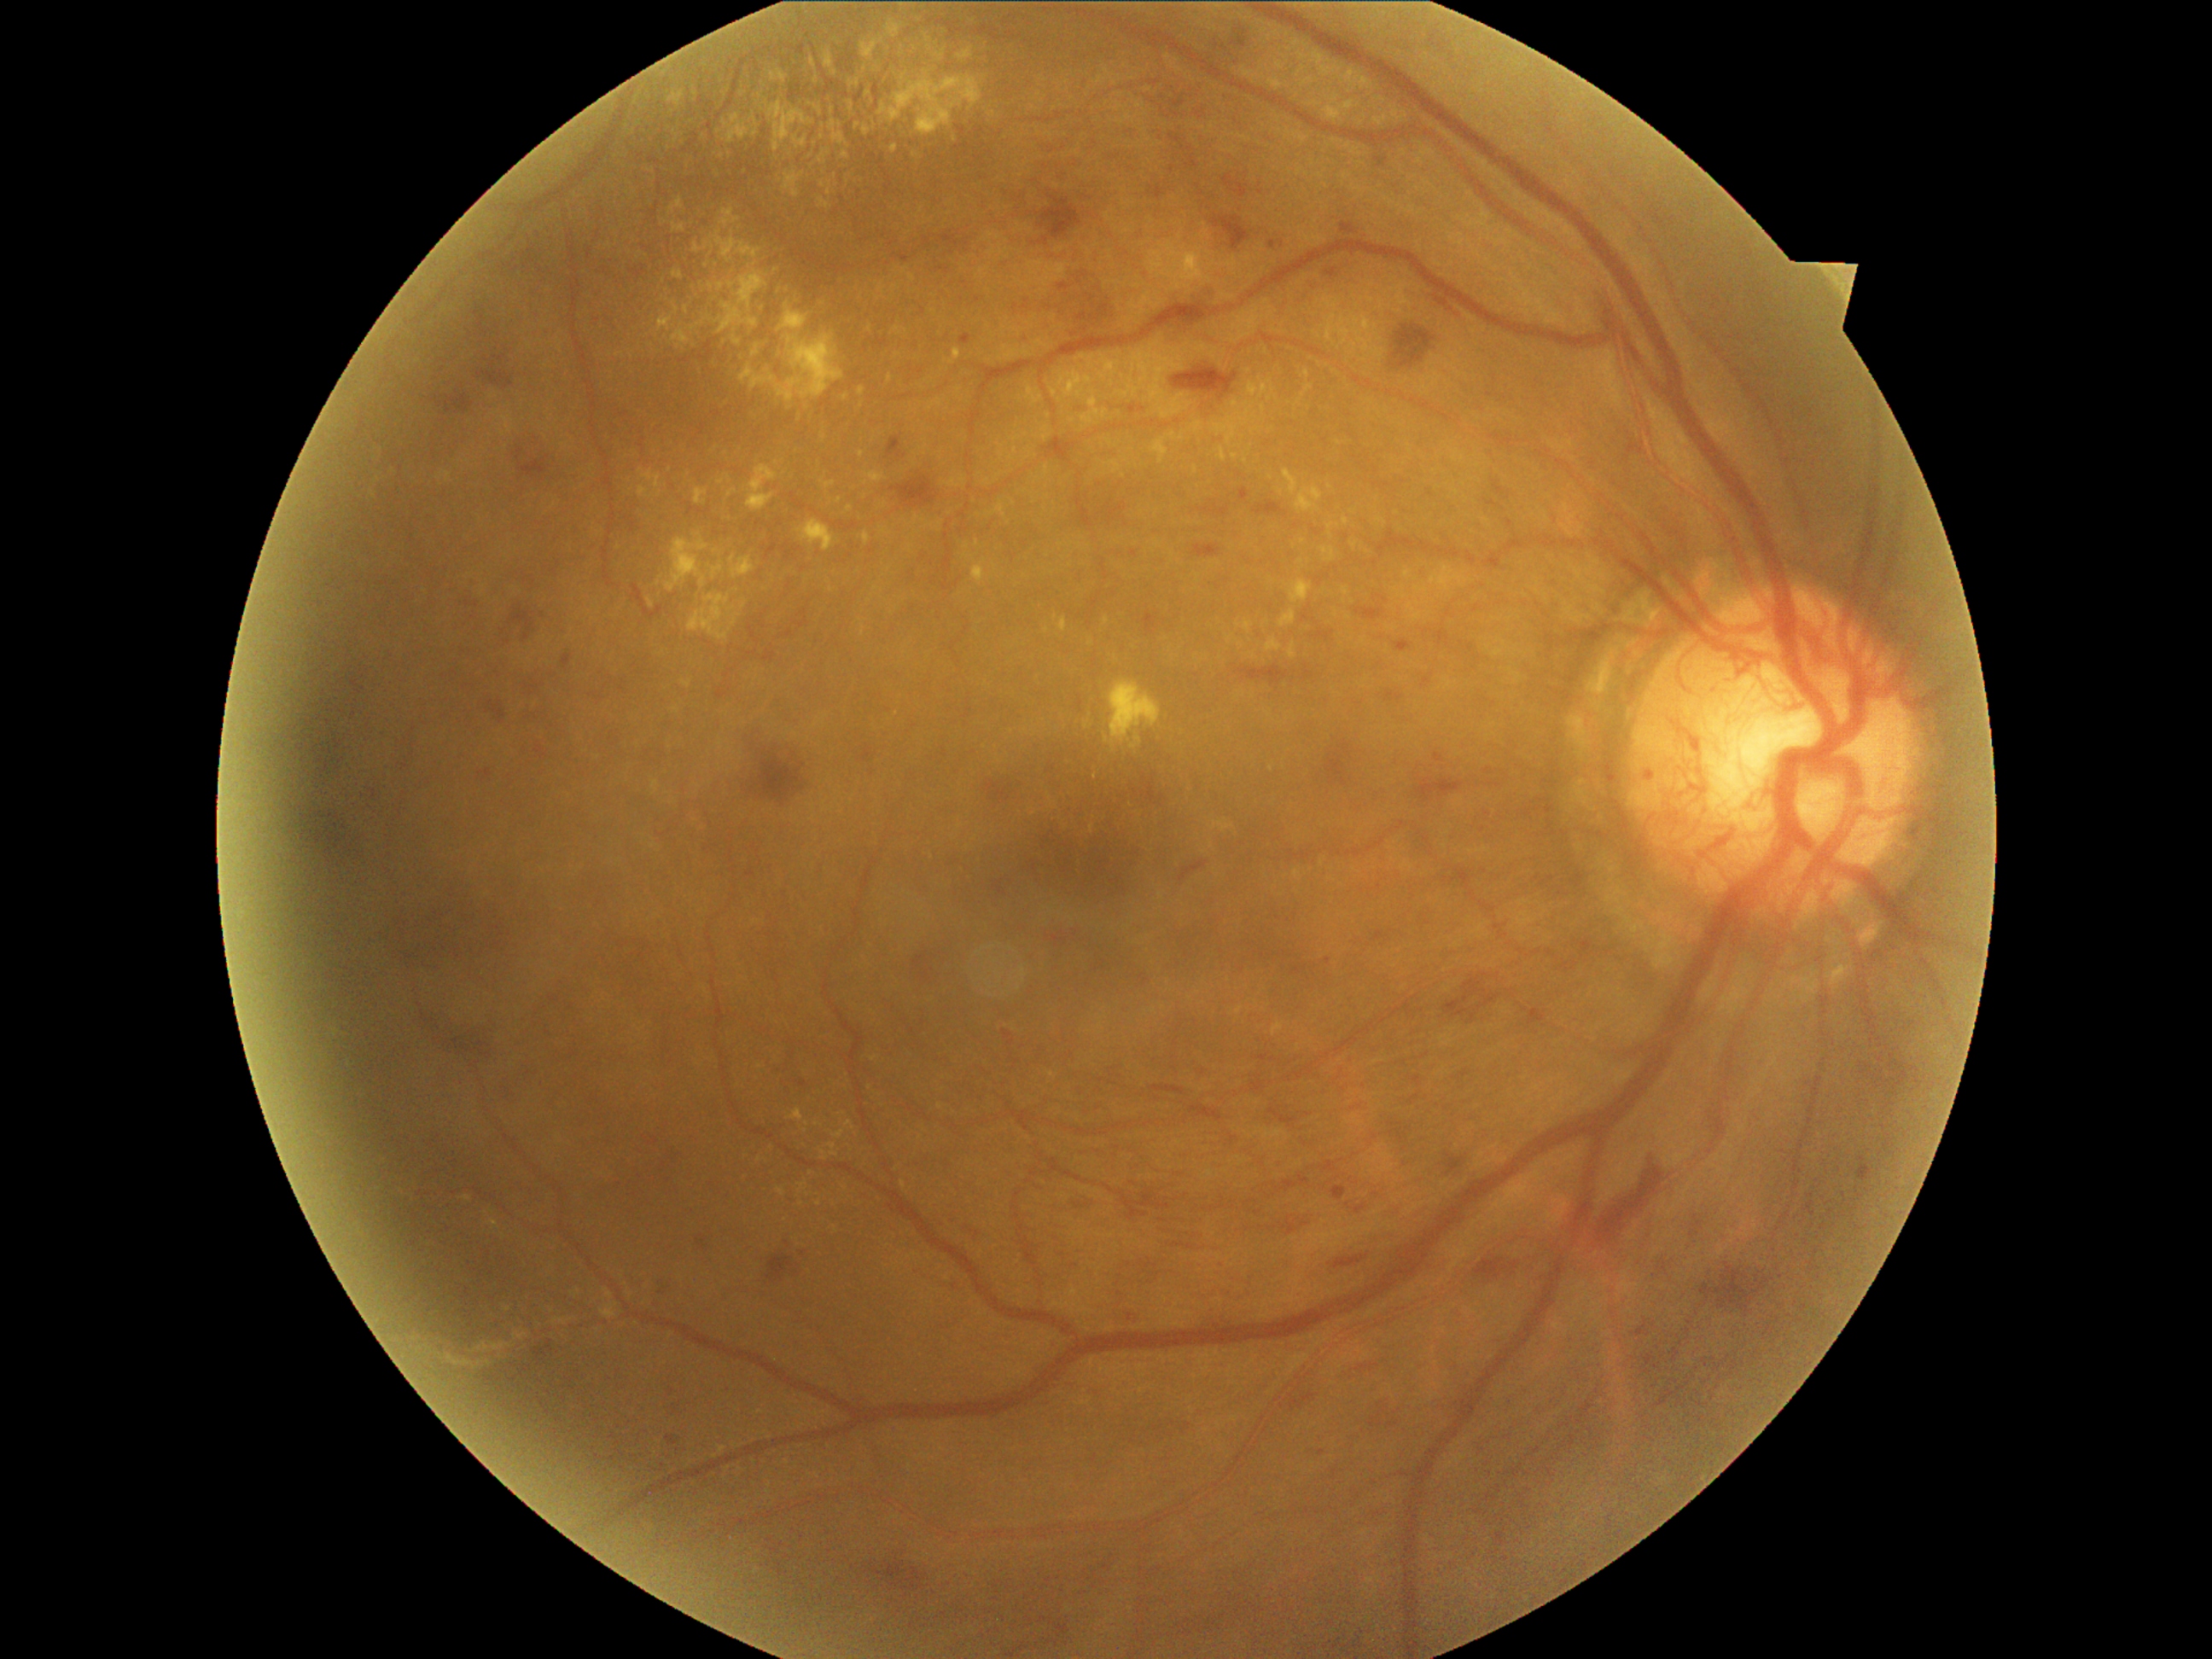

Diabetic retinopathy (DR): 4/4 — neovascularization and/or vitreous/pre-retinal hemorrhage
Lesions identified (partial list):
* hard exudates (EXs) (continued): left=1119, top=383, right=1136, bottom=402; left=887, top=23, right=900, bottom=38; left=1231, top=402, right=1240, bottom=409; left=1284, top=469, right=1300, bottom=496; left=672, top=271, right=682, bottom=279; left=696, top=489, right=709, bottom=506; left=846, top=1121, right=856, bottom=1131; left=706, top=242, right=714, bottom=250; left=1220, top=446, right=1228, bottom=462; left=1346, top=71, right=1356, bottom=88; left=463, top=1196, right=472, bottom=1202; left=685, top=306, right=690, bottom=315; left=689, top=595, right=731, bottom=641; left=866, top=62, right=885, bottom=98
* Small EXs near 823:184; 1272:390; 507:1310; 956:141; 833:1153; 819:1203